1932 by 1916 pixels — 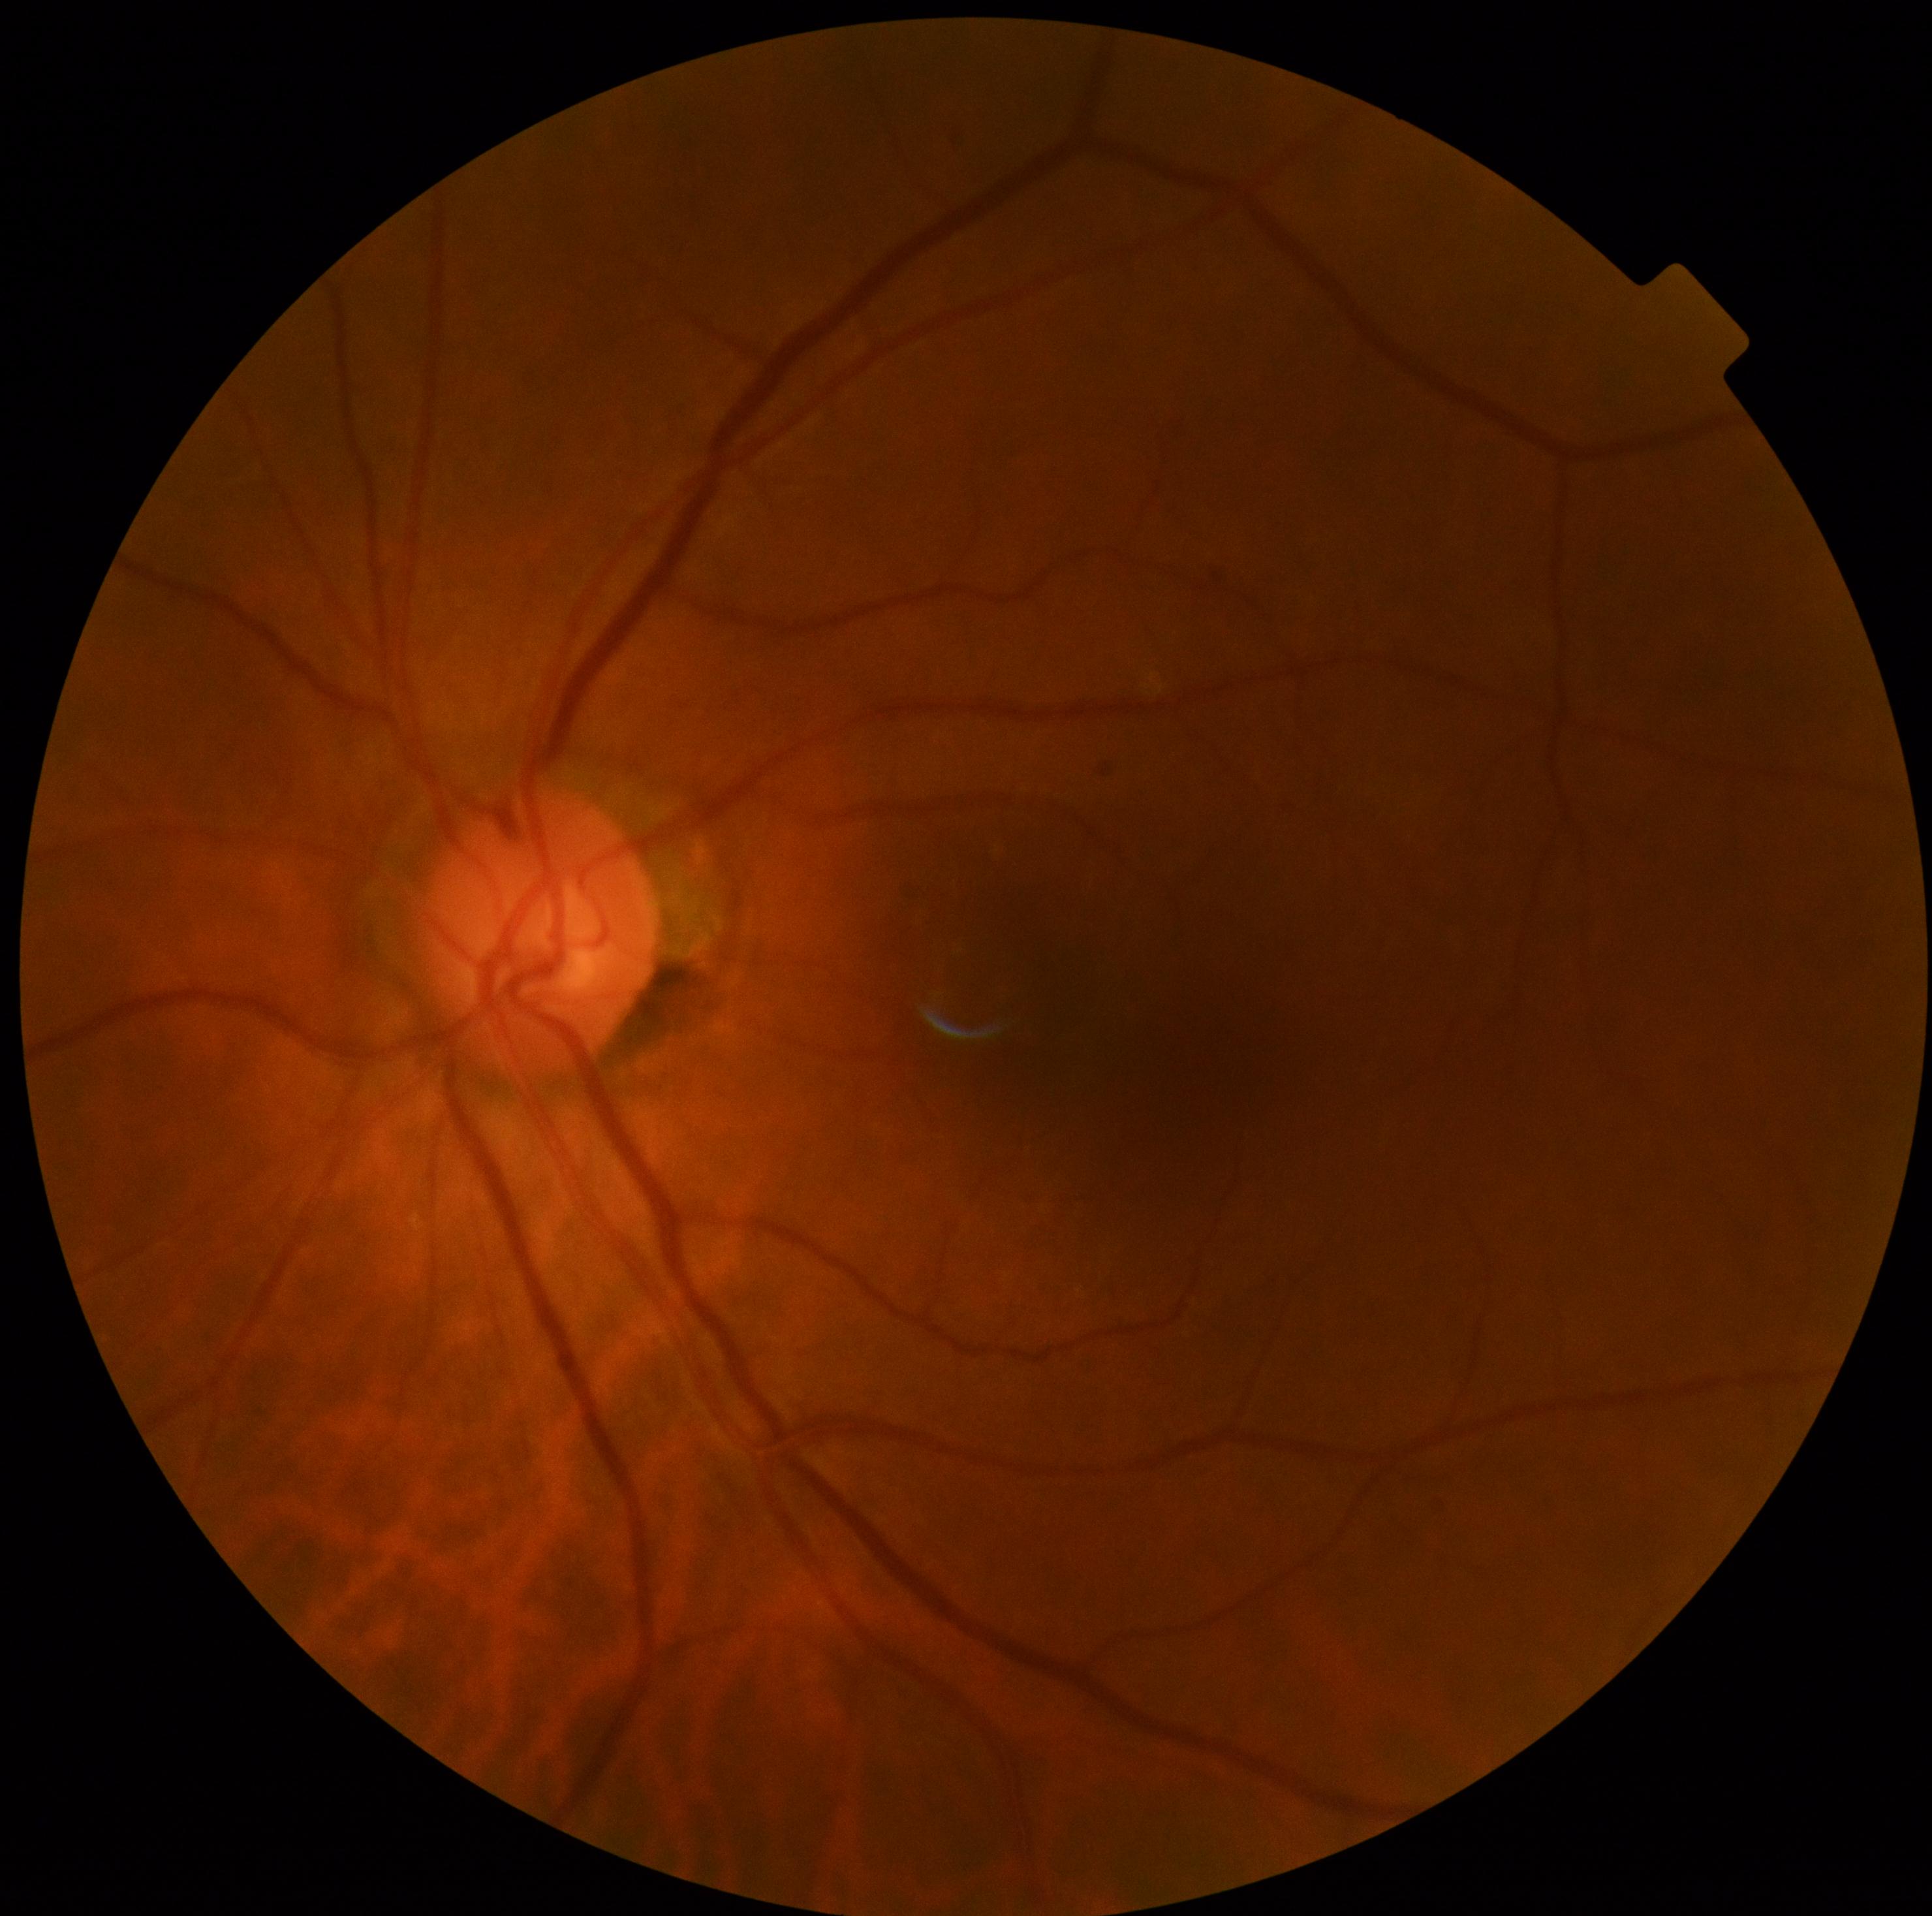
DR severity is 0 — no visible signs of diabetic retinopathy. No signs of diabetic retinopathy.